CFP.
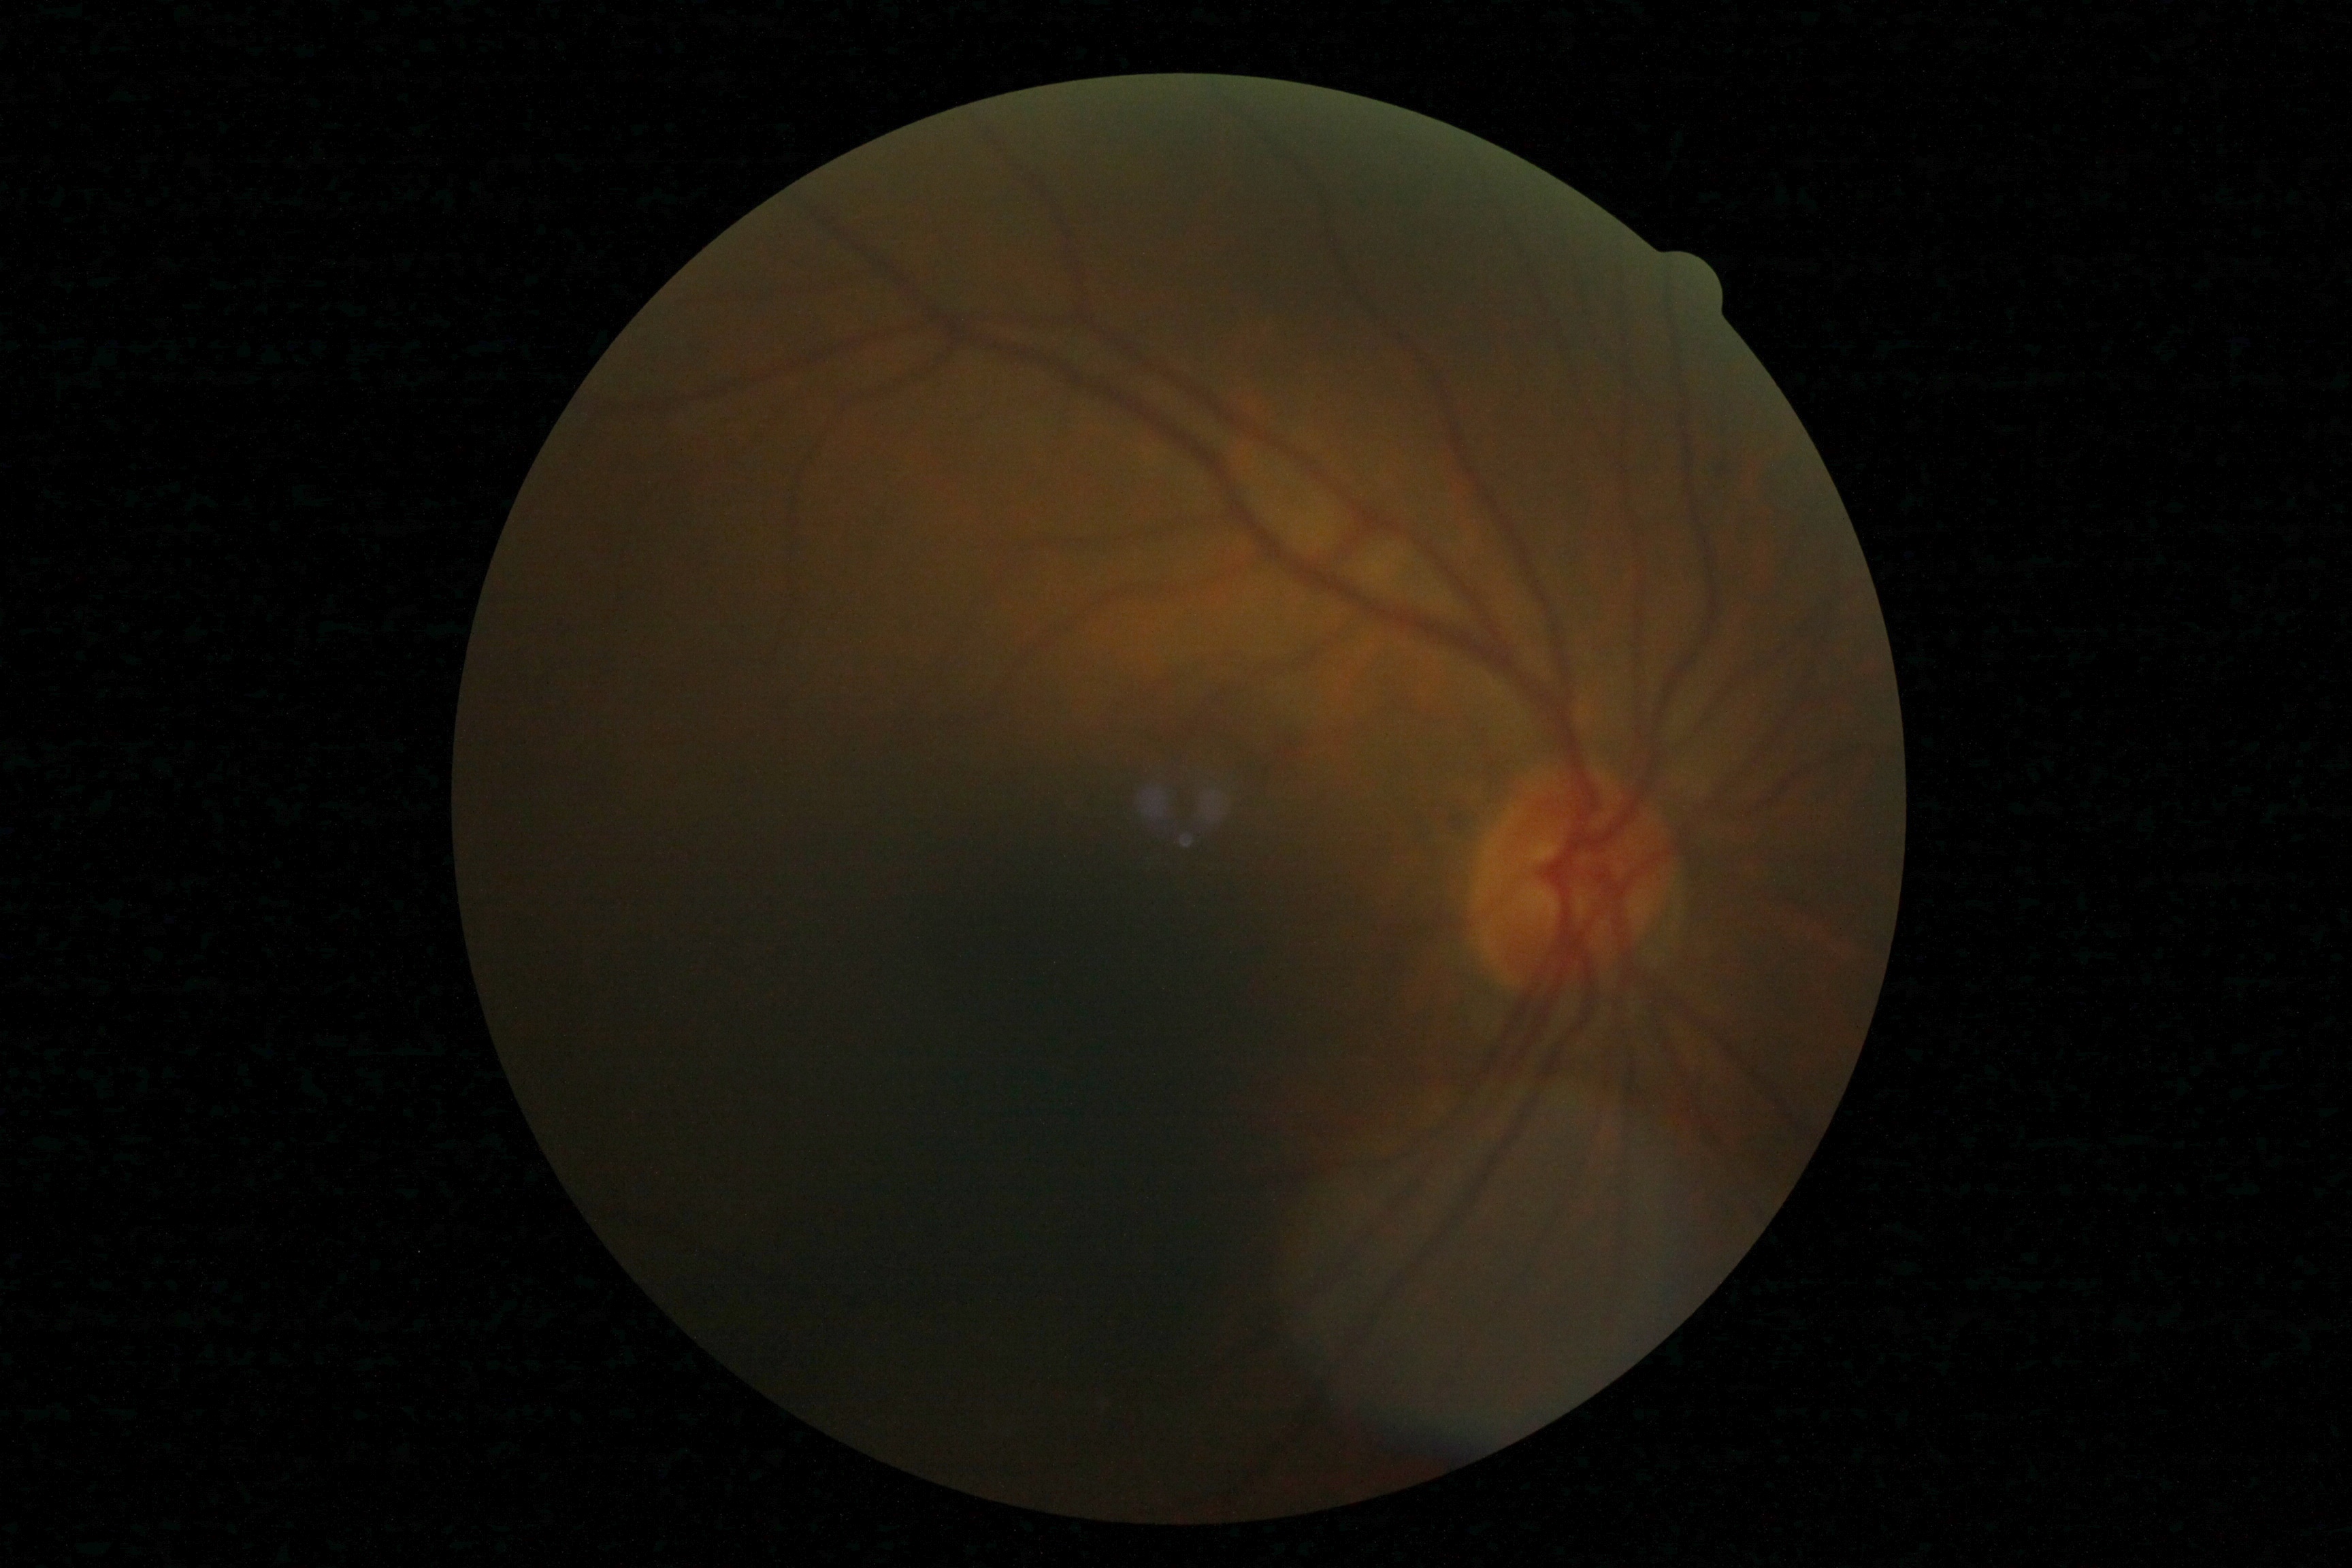 Diabetic retinopathy severity: grade 0 (no apparent retinopathy) — no visible signs of diabetic retinopathy.